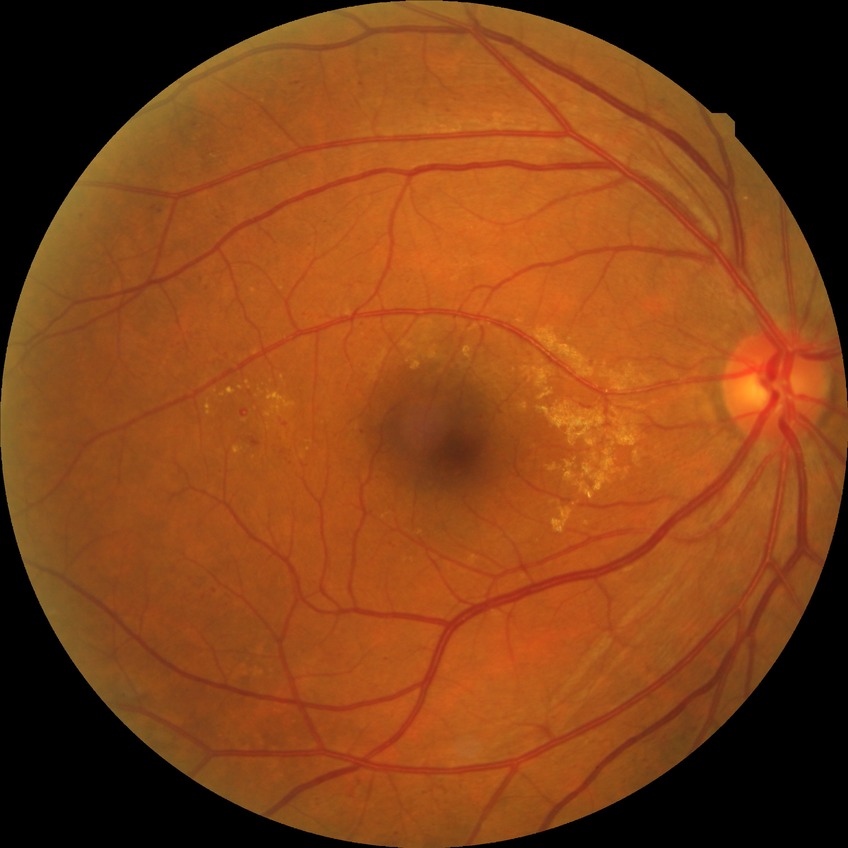 Davis DR grade is SDR.